2352x1568, 45° FOV: 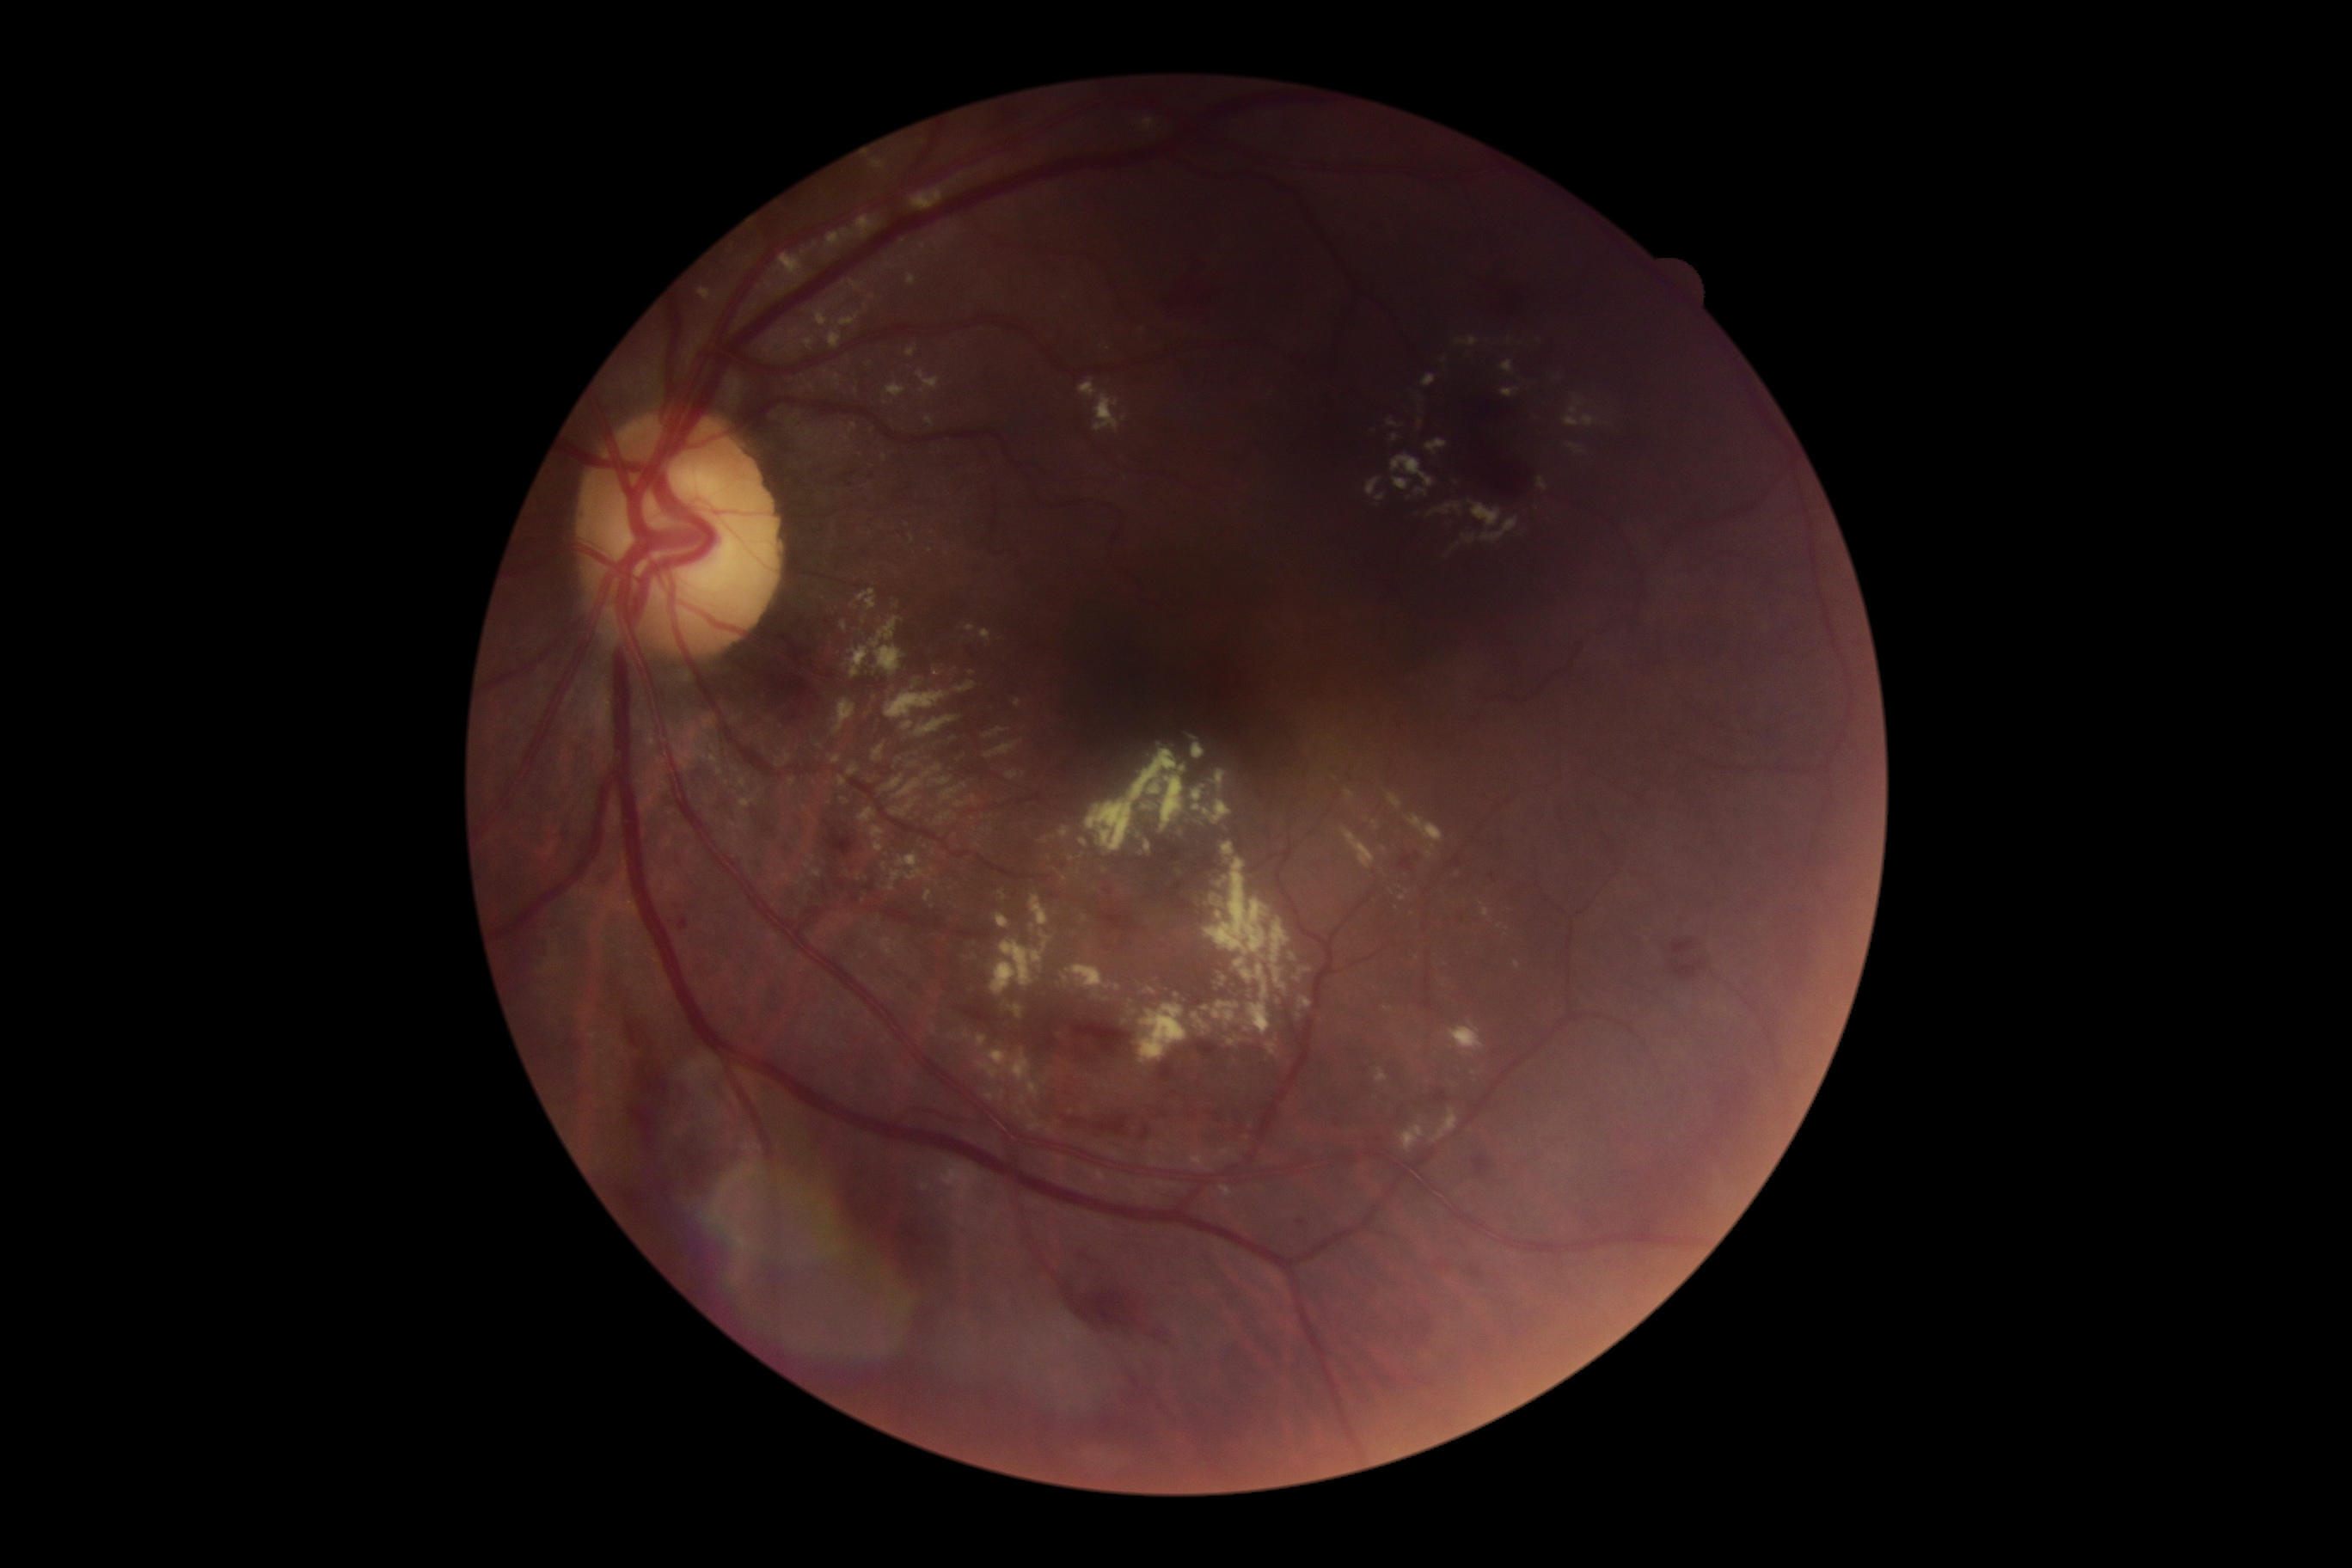
Annotations:
* DR severity — grade 2 (moderate NPDR)